No pharmacologic dilation — 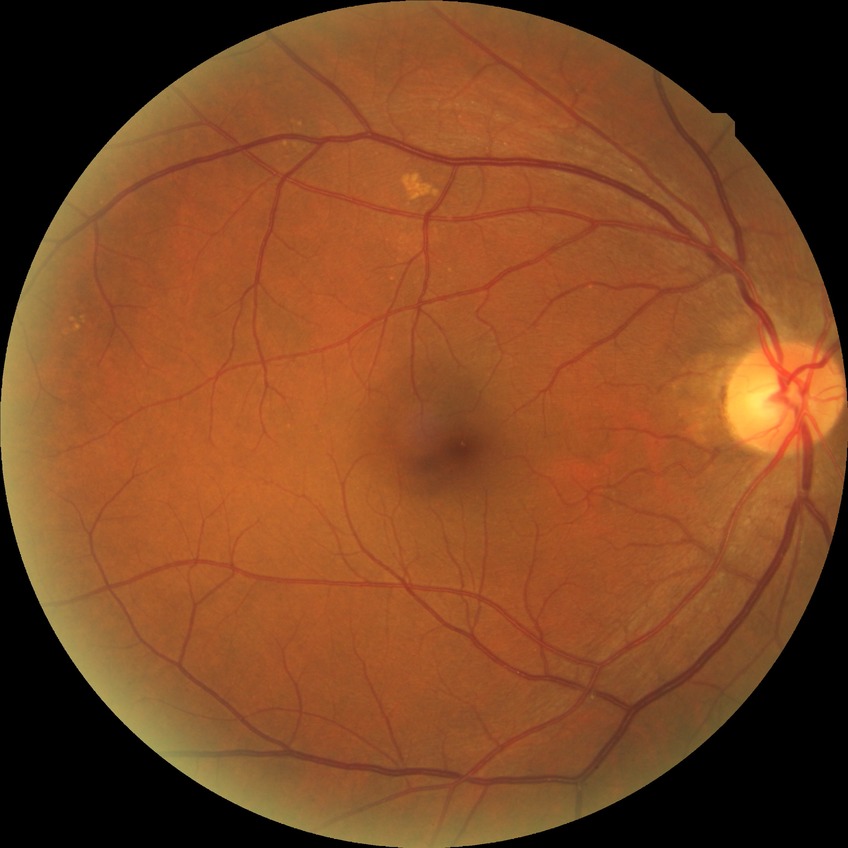 diabetic retinopathy (DR)@no diabetic retinopathy (NDR).